45° field of view. 2352x1568px. Retinal fundus photograph.
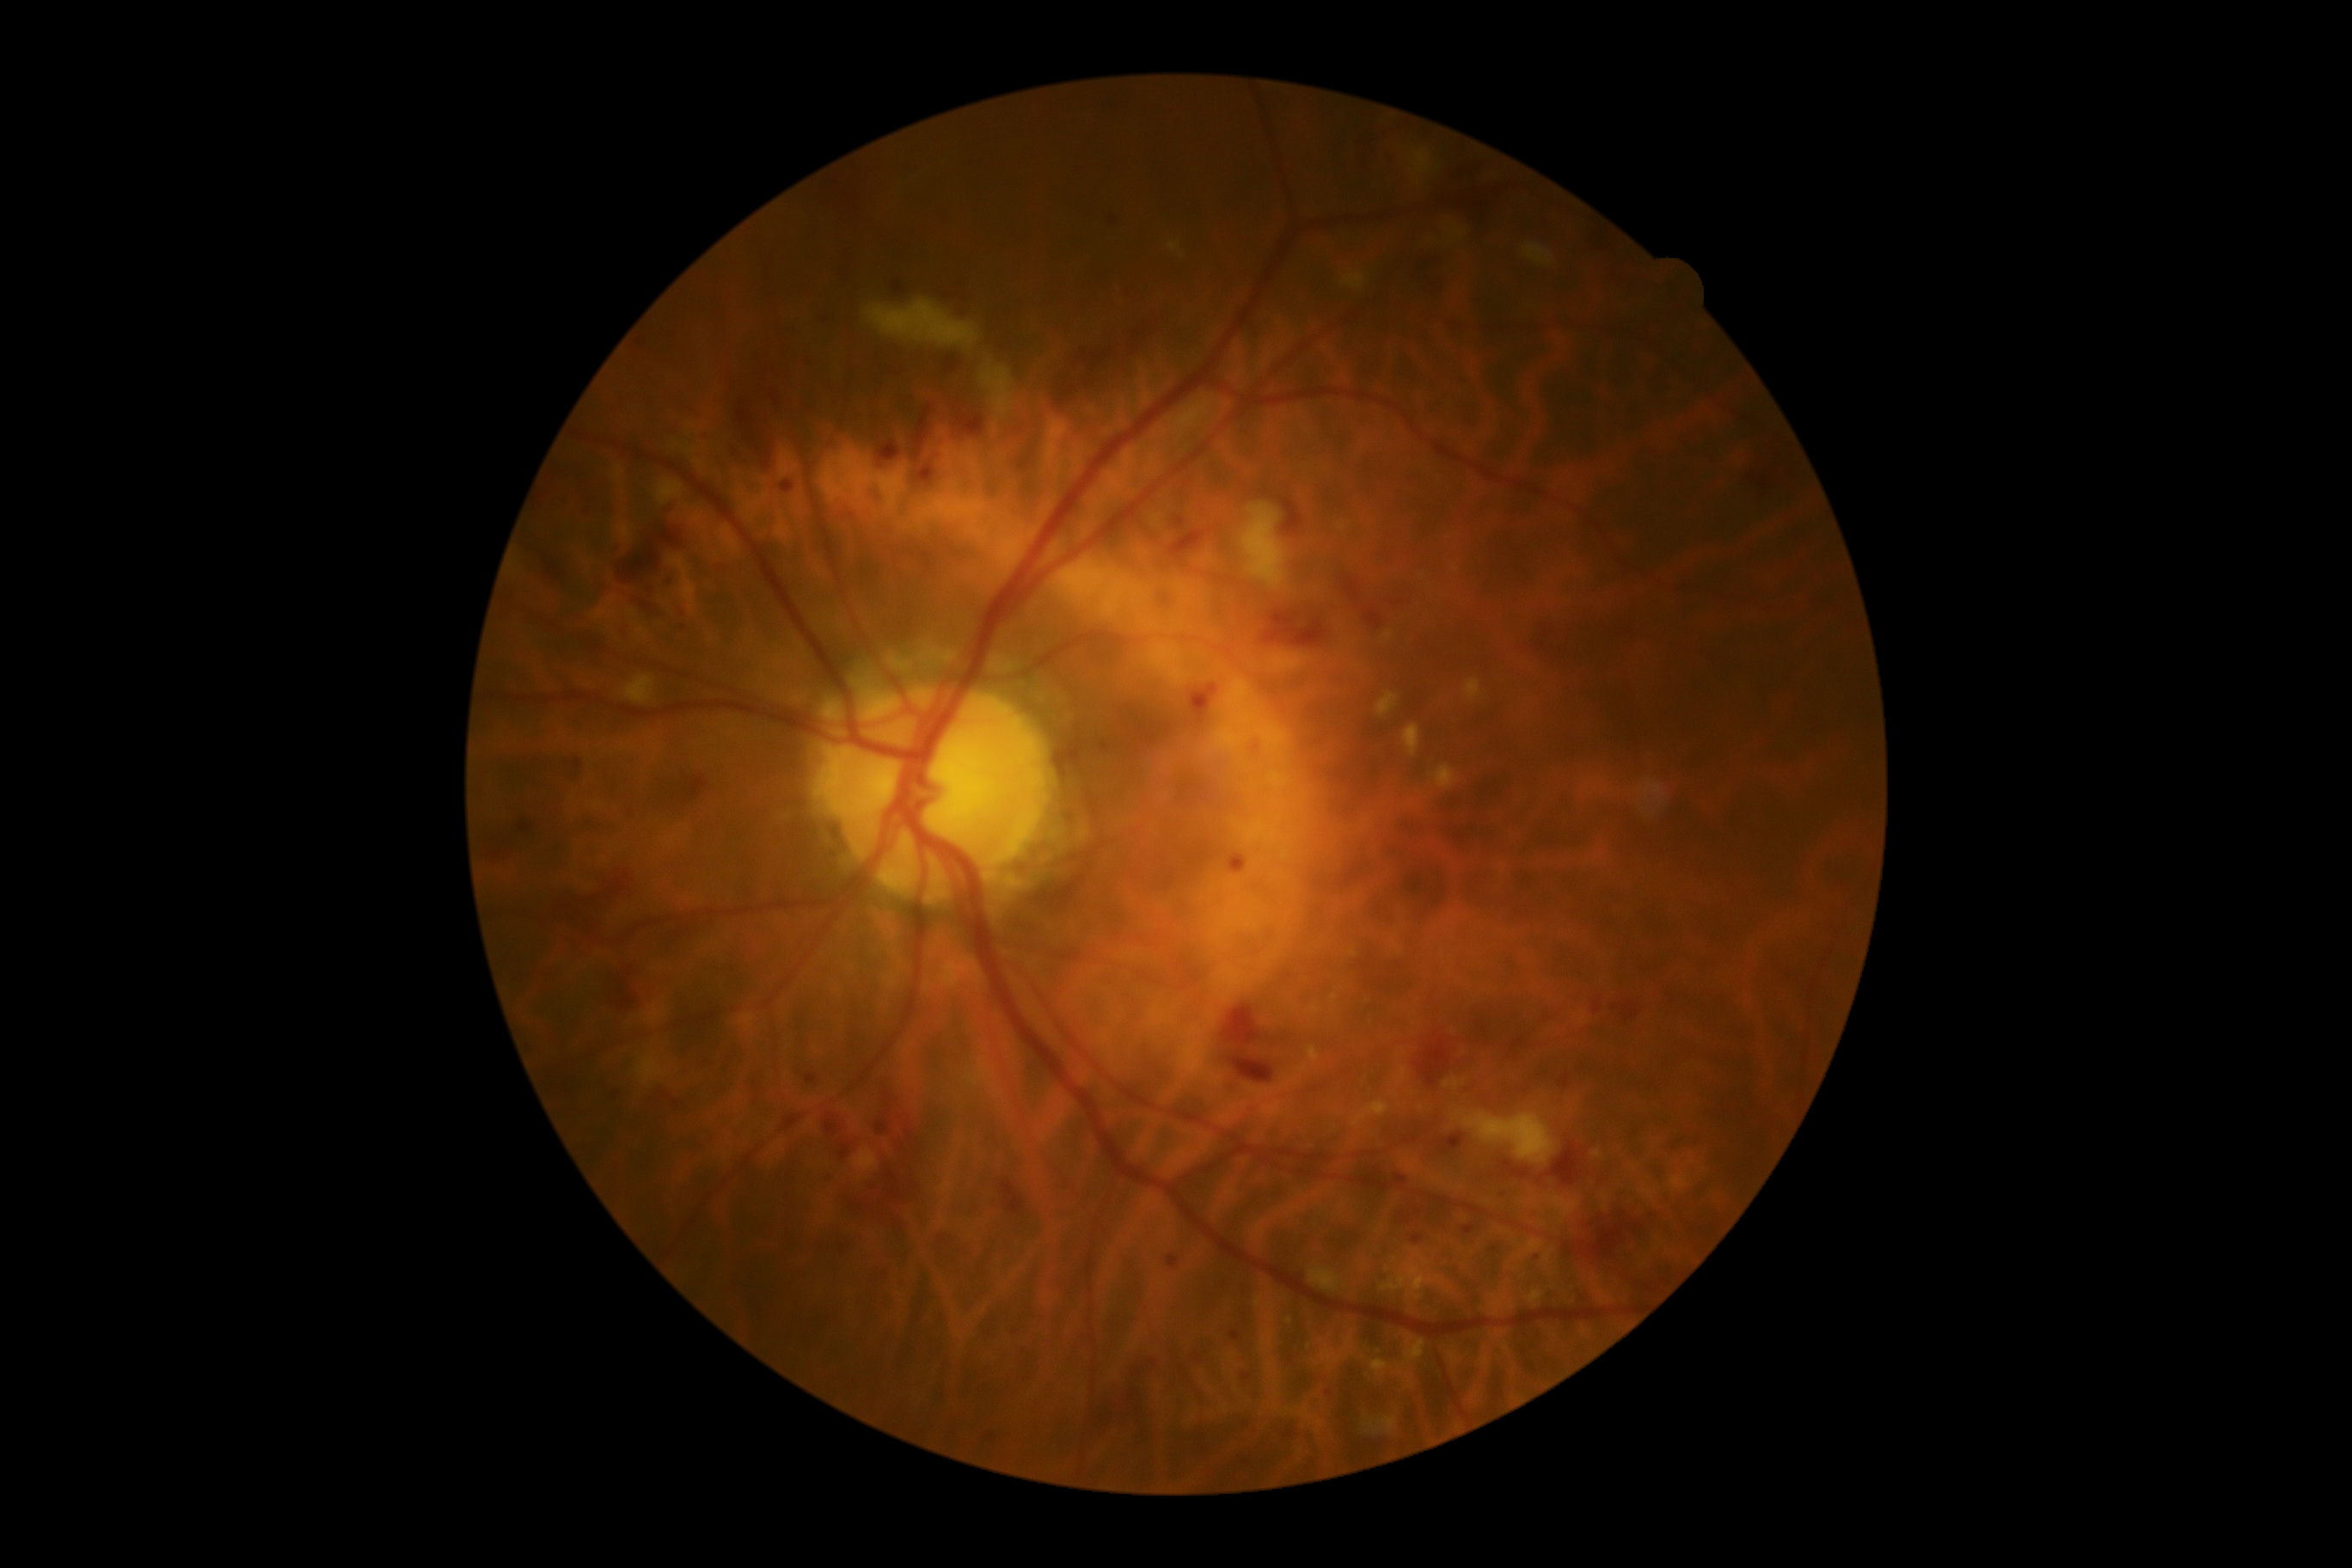
diabetic retinopathy (DR): moderate NPDR (grade 2).